CFP; 50° FOV:
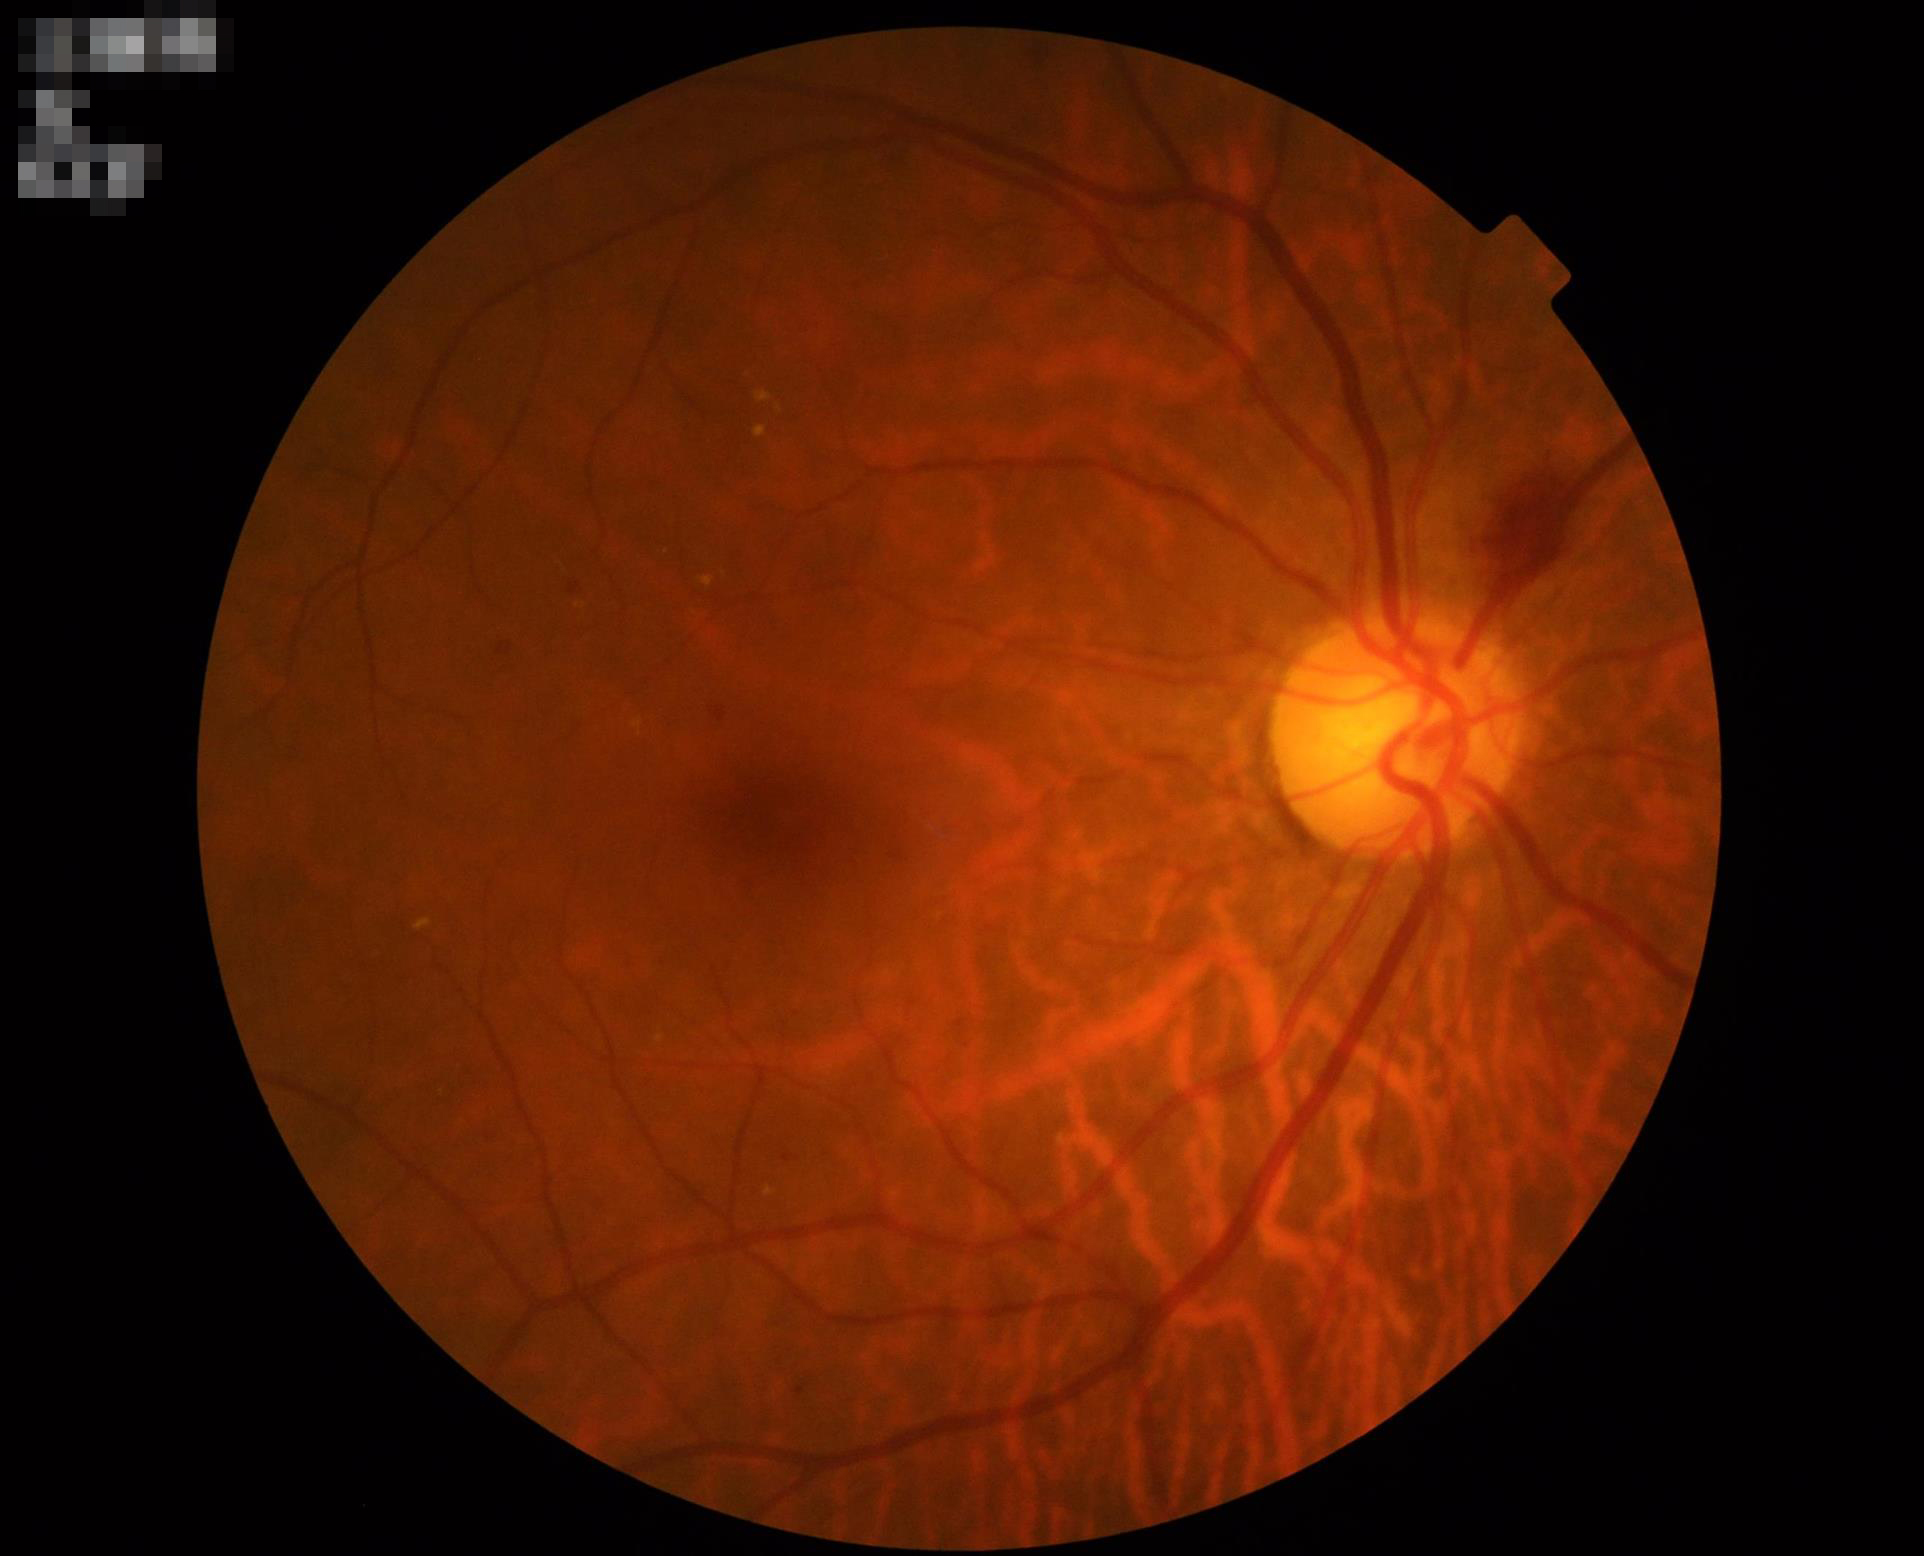   contrast: vessels and details readily distinguishable
  illumination: uniform, no color cast
  overall_quality: good, gradable
  clarity: optic disc, vessels, and background in focus